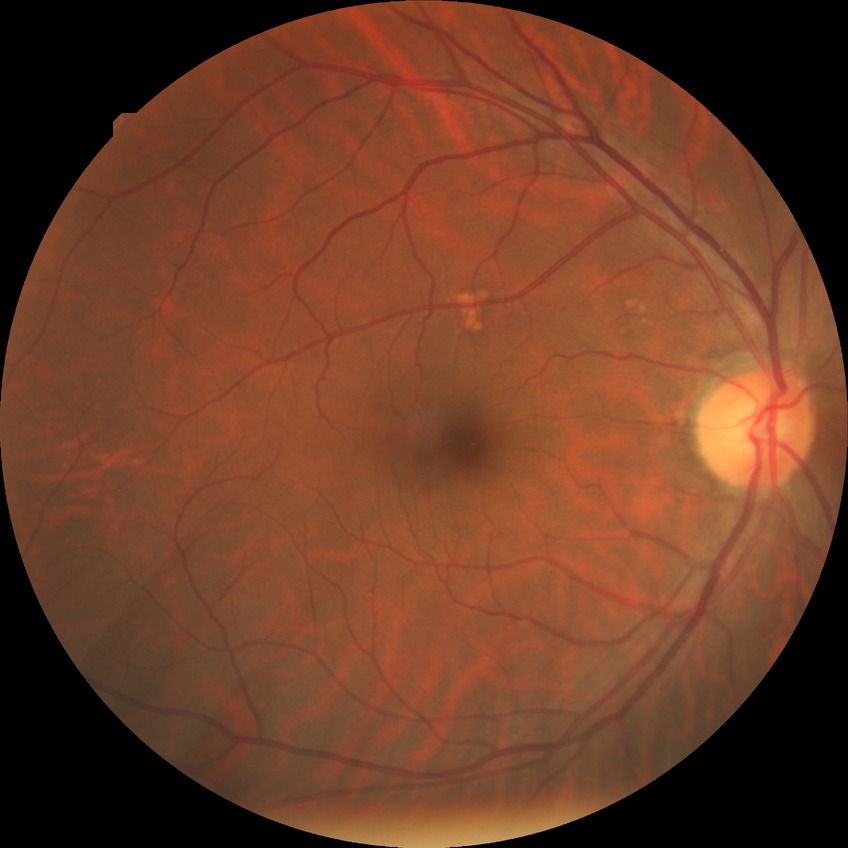
- diabetic retinopathy (DR): SDR (simple diabetic retinopathy)